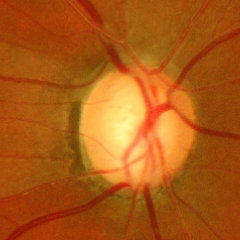
Glaucoma is present. Assessment: advanced glaucoma.